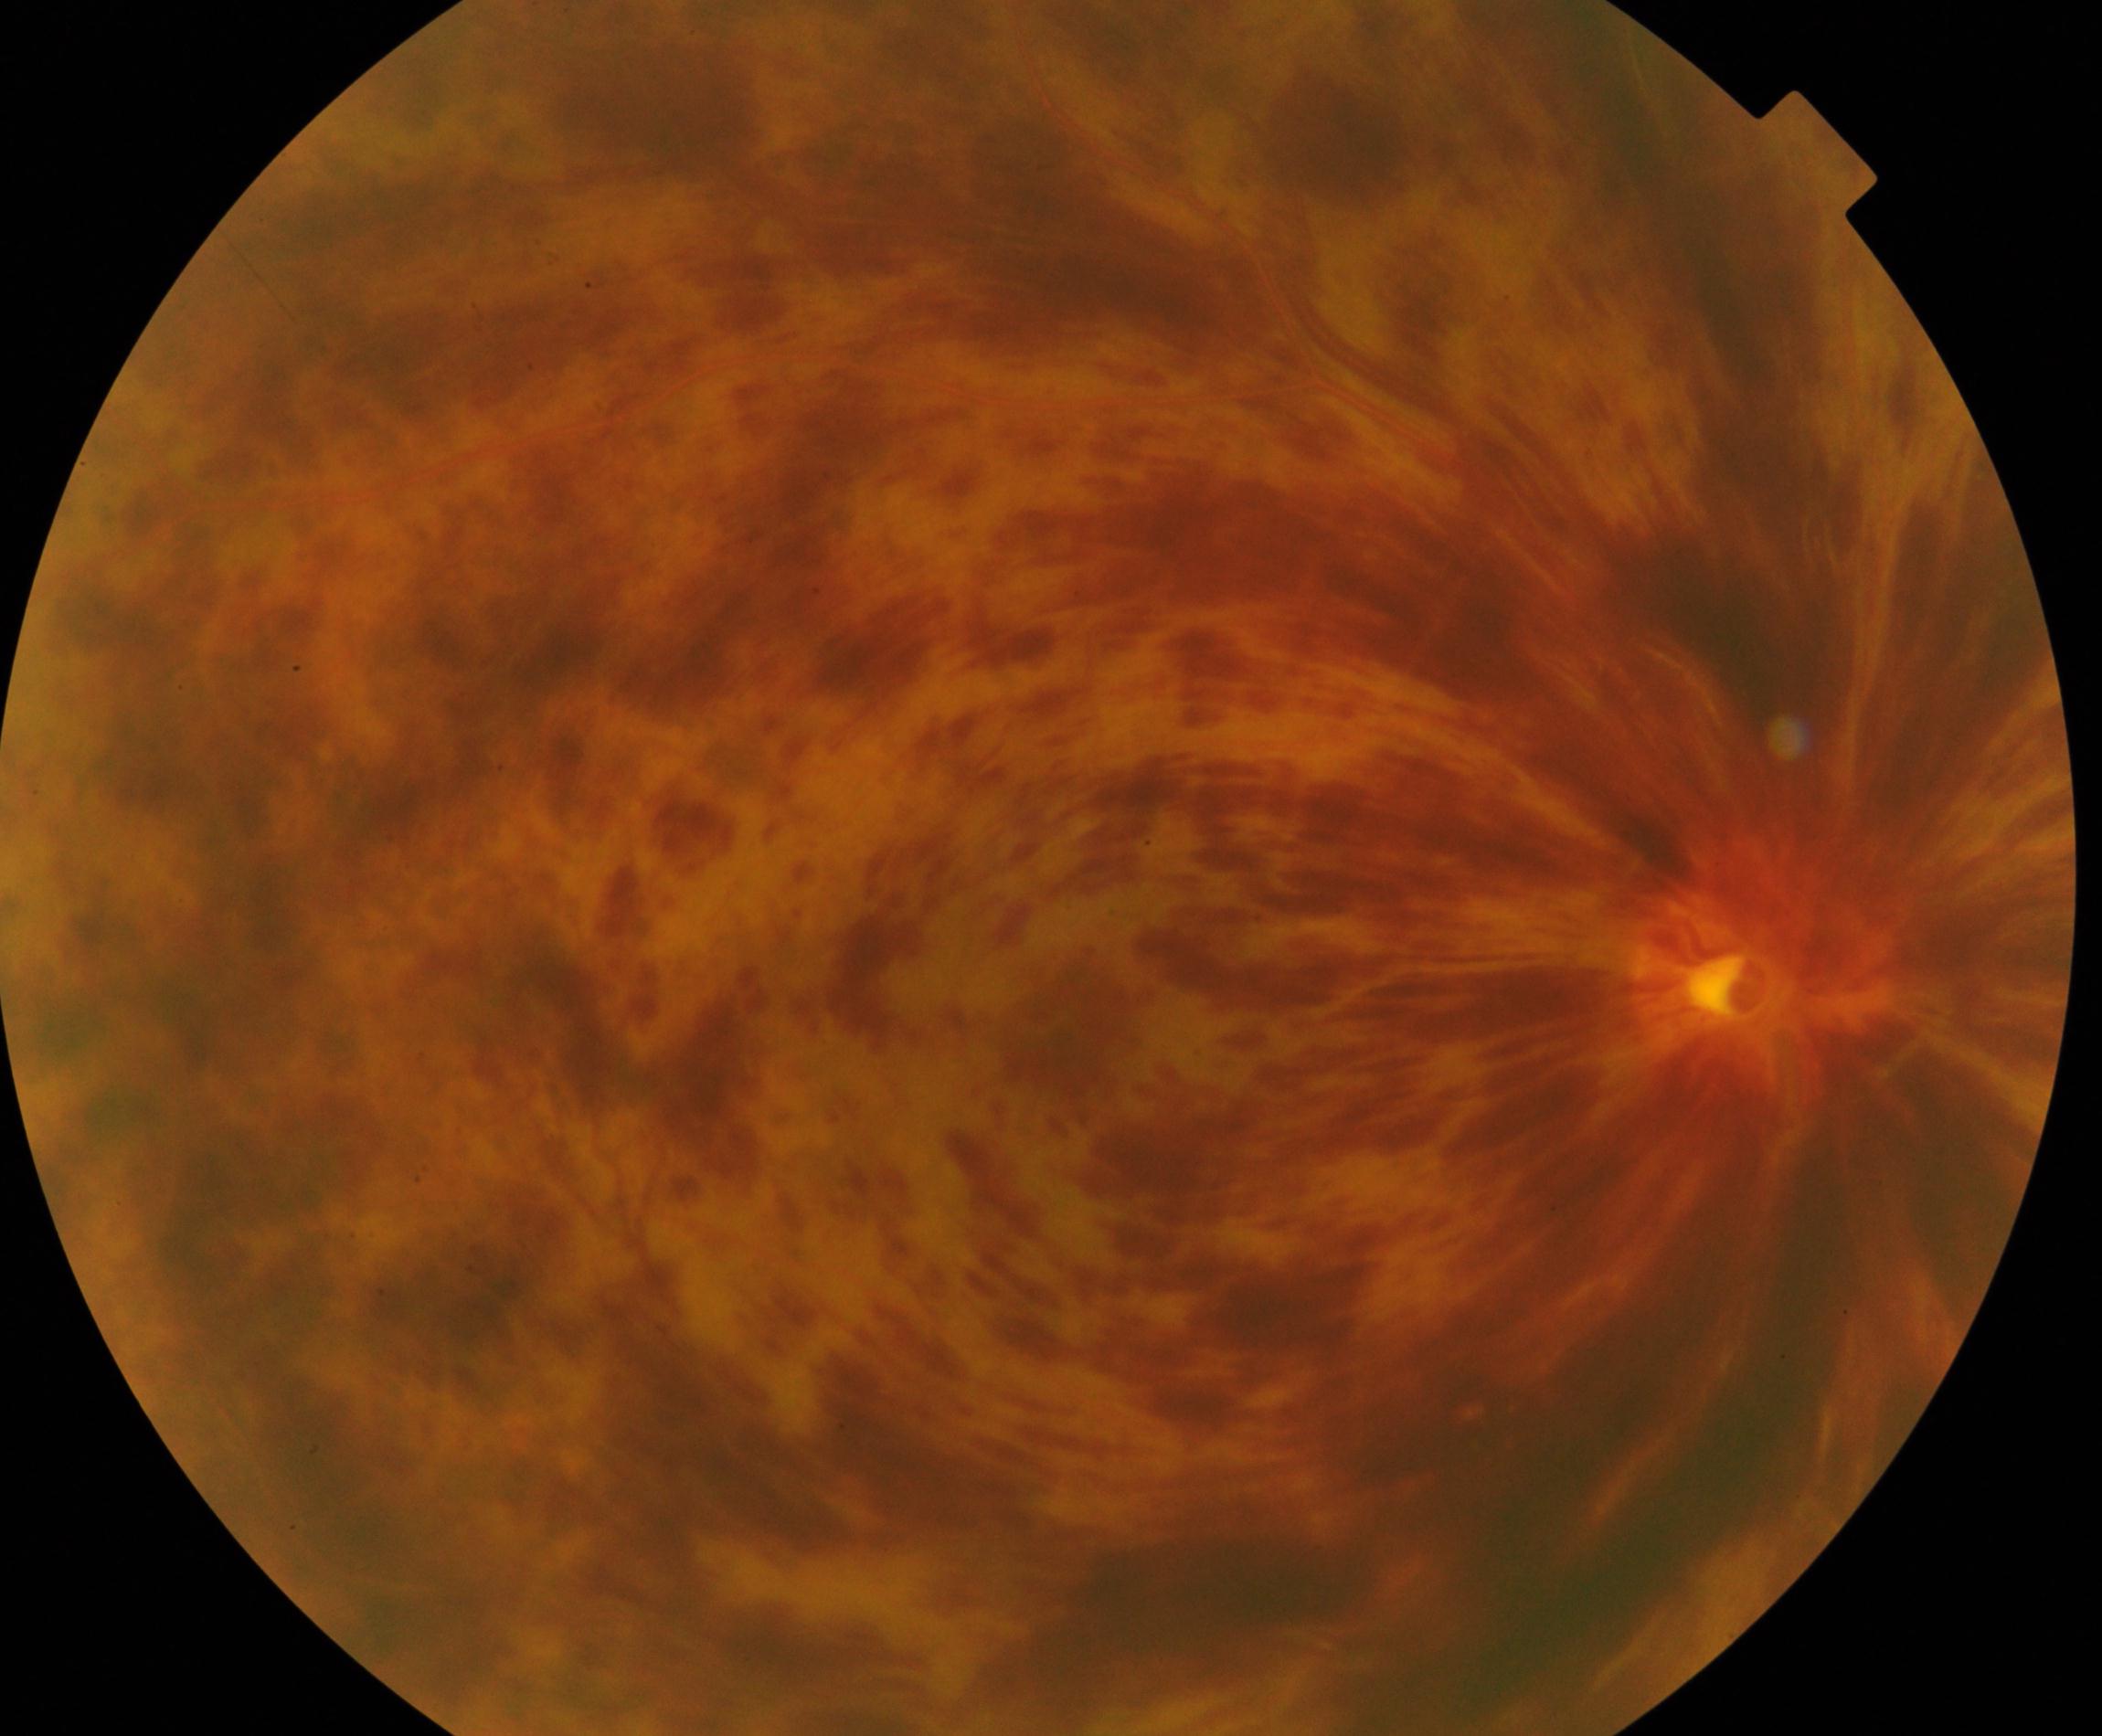 Findings: central retinal vein occlusion (CRVO).